No pharmacologic dilation — 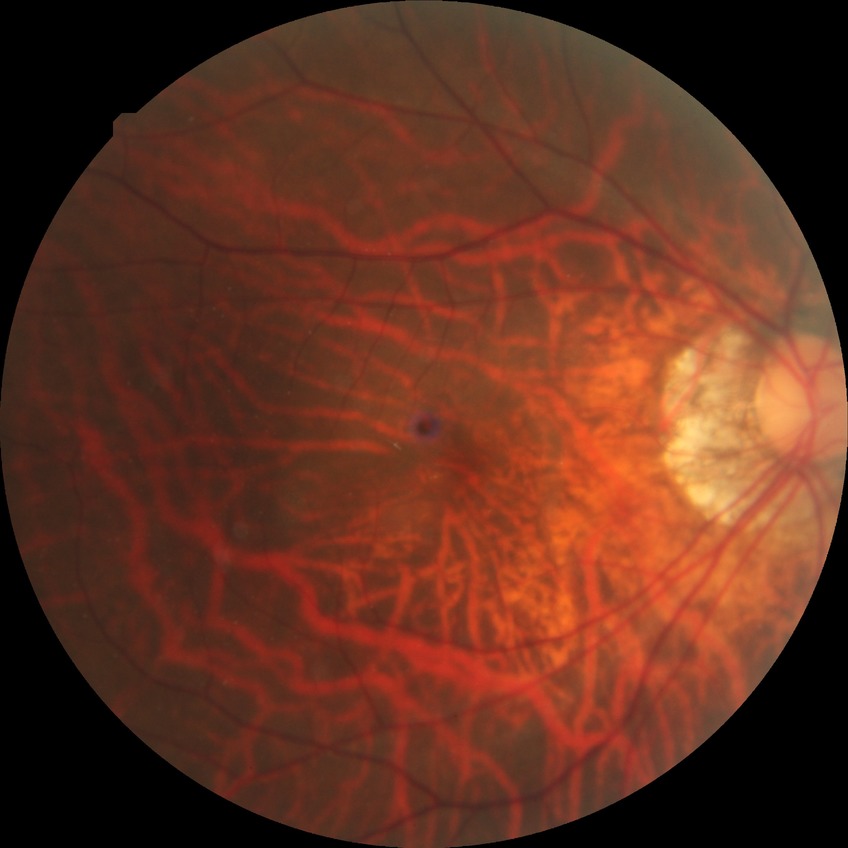
Retinopathy grade is no diabetic retinopathy.